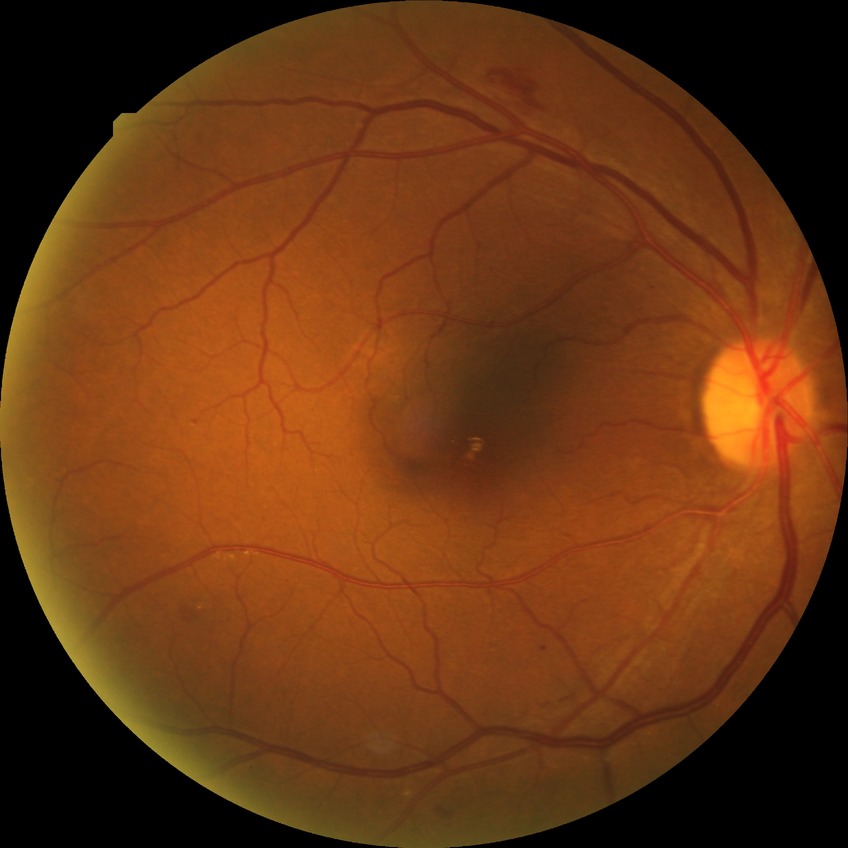
Davis grading is simple diabetic retinopathy.